Image size 1932x1932: 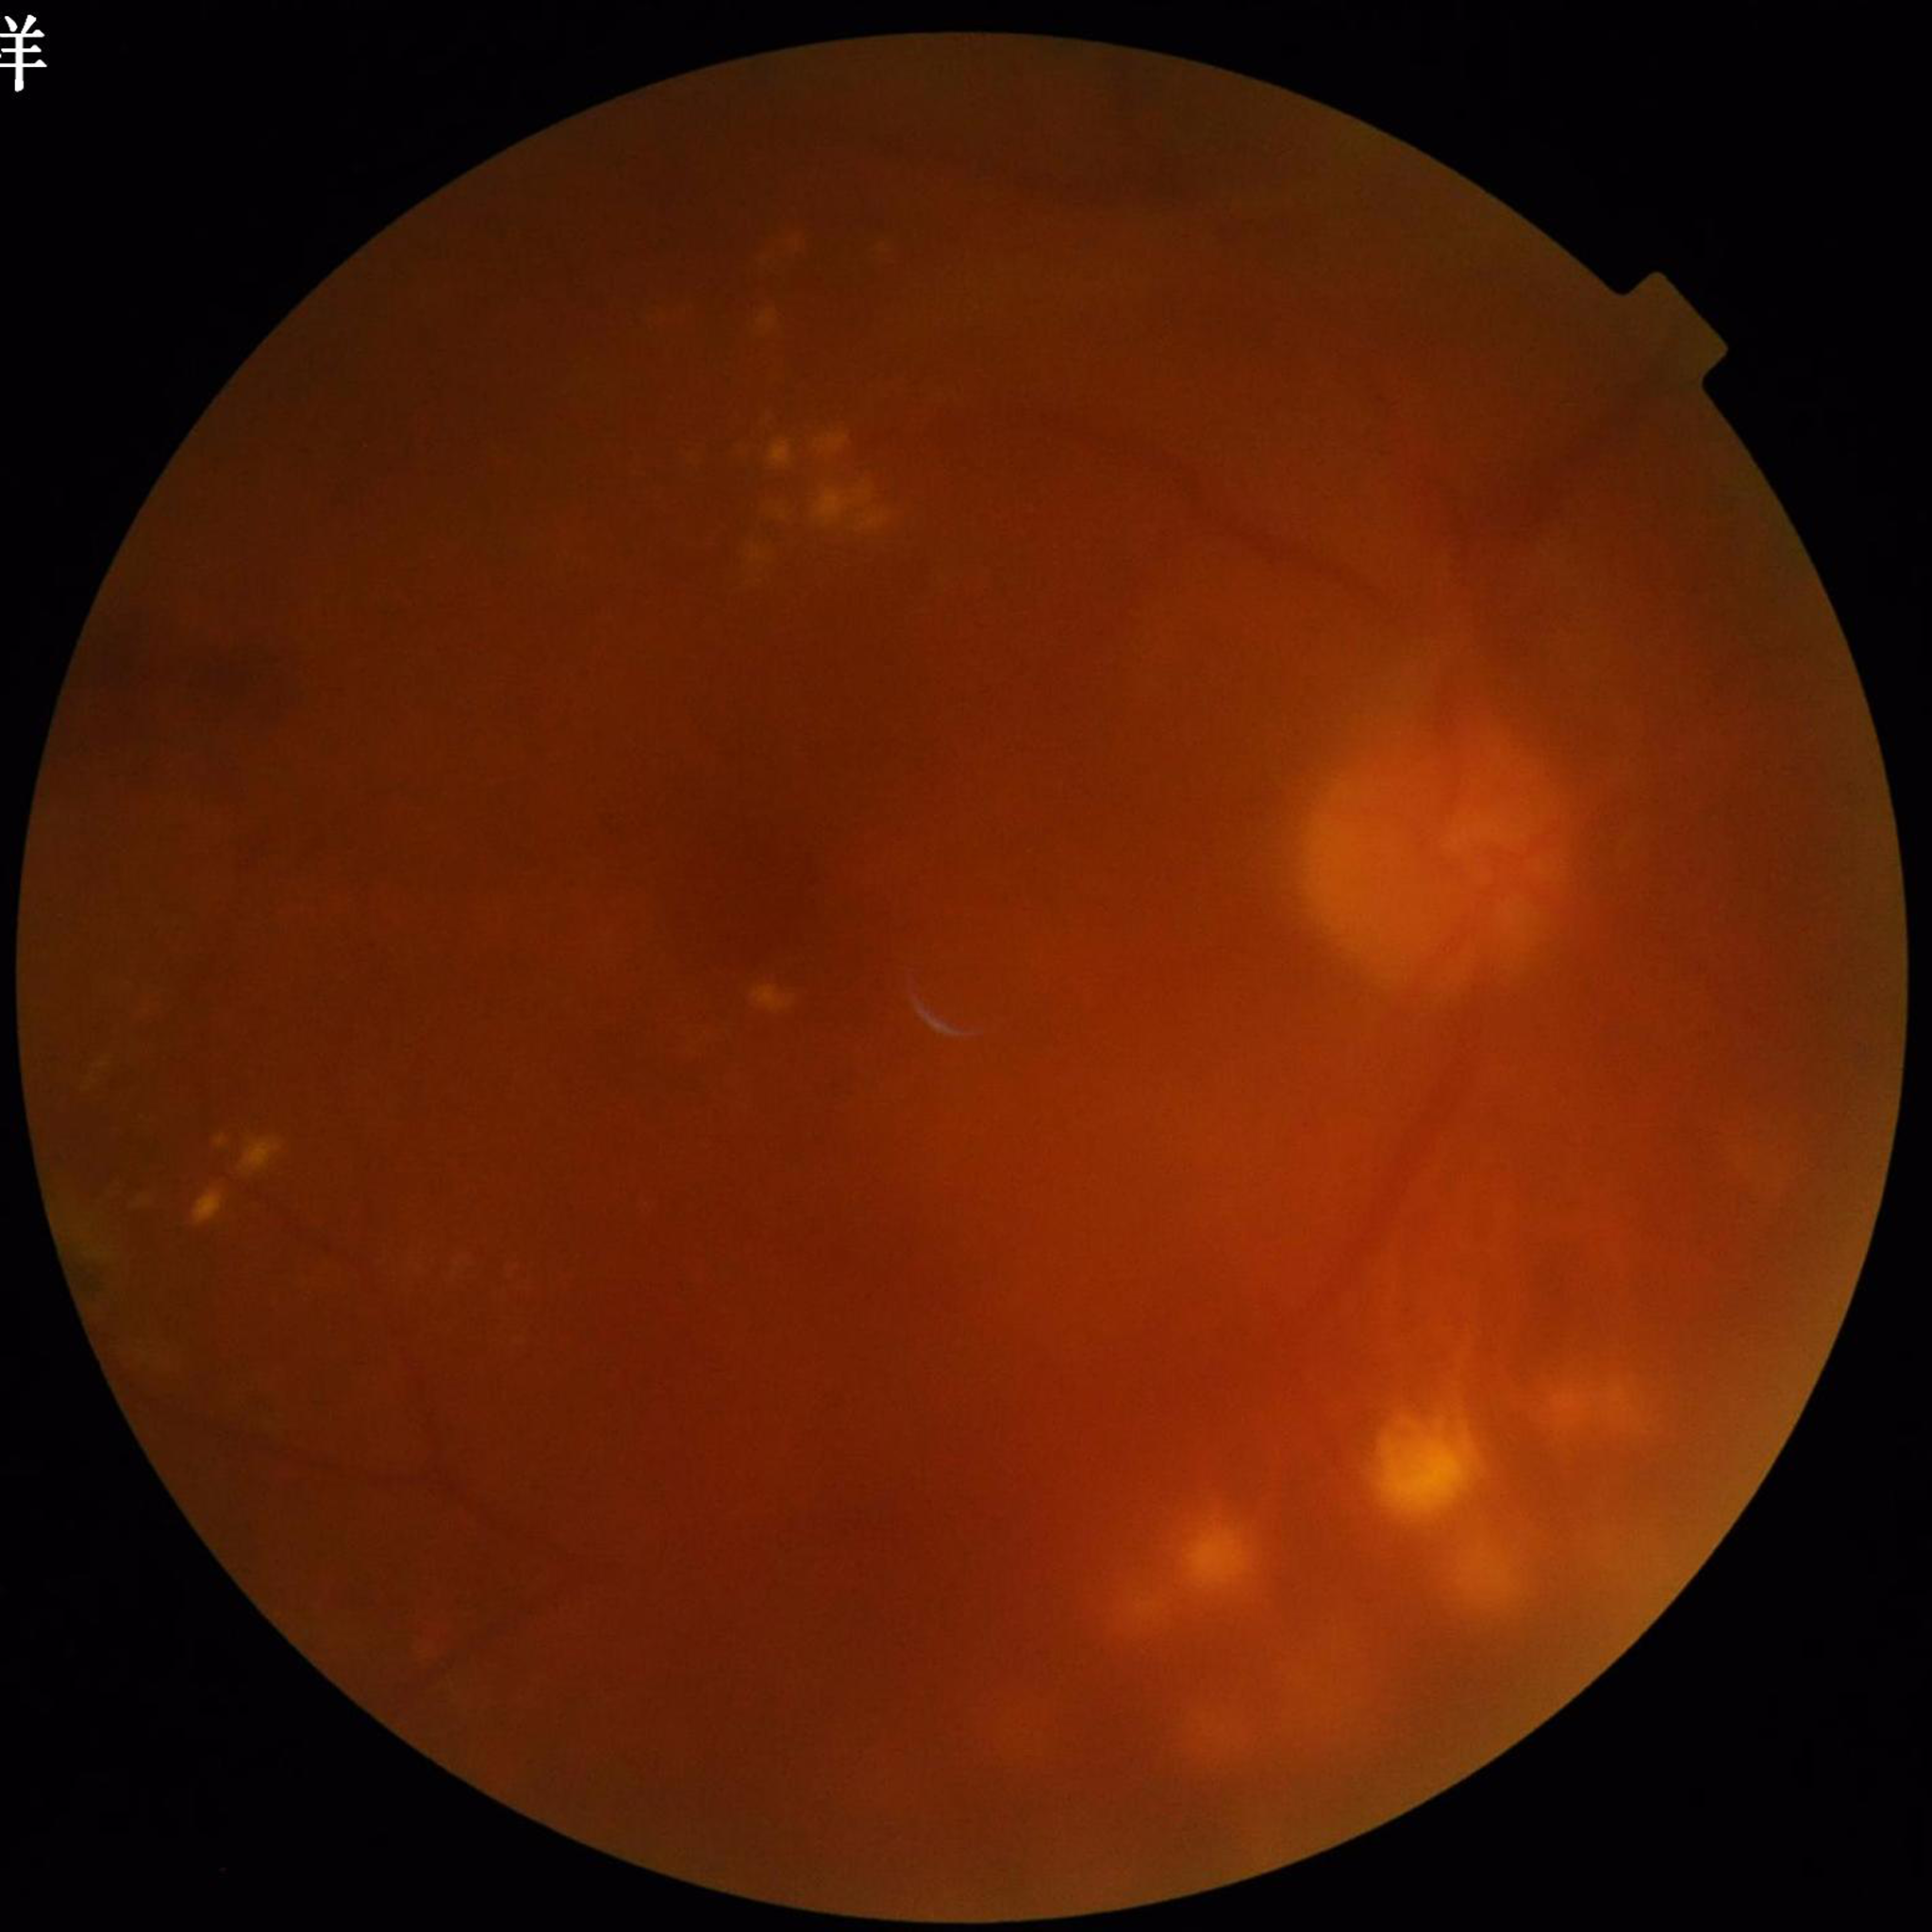 Quality assessment: reduced — blur, illumination/color distortion. Color fundus photograph from a patient diagnosed with diabetic retinopathy (DR).